Image size 2352x1568: 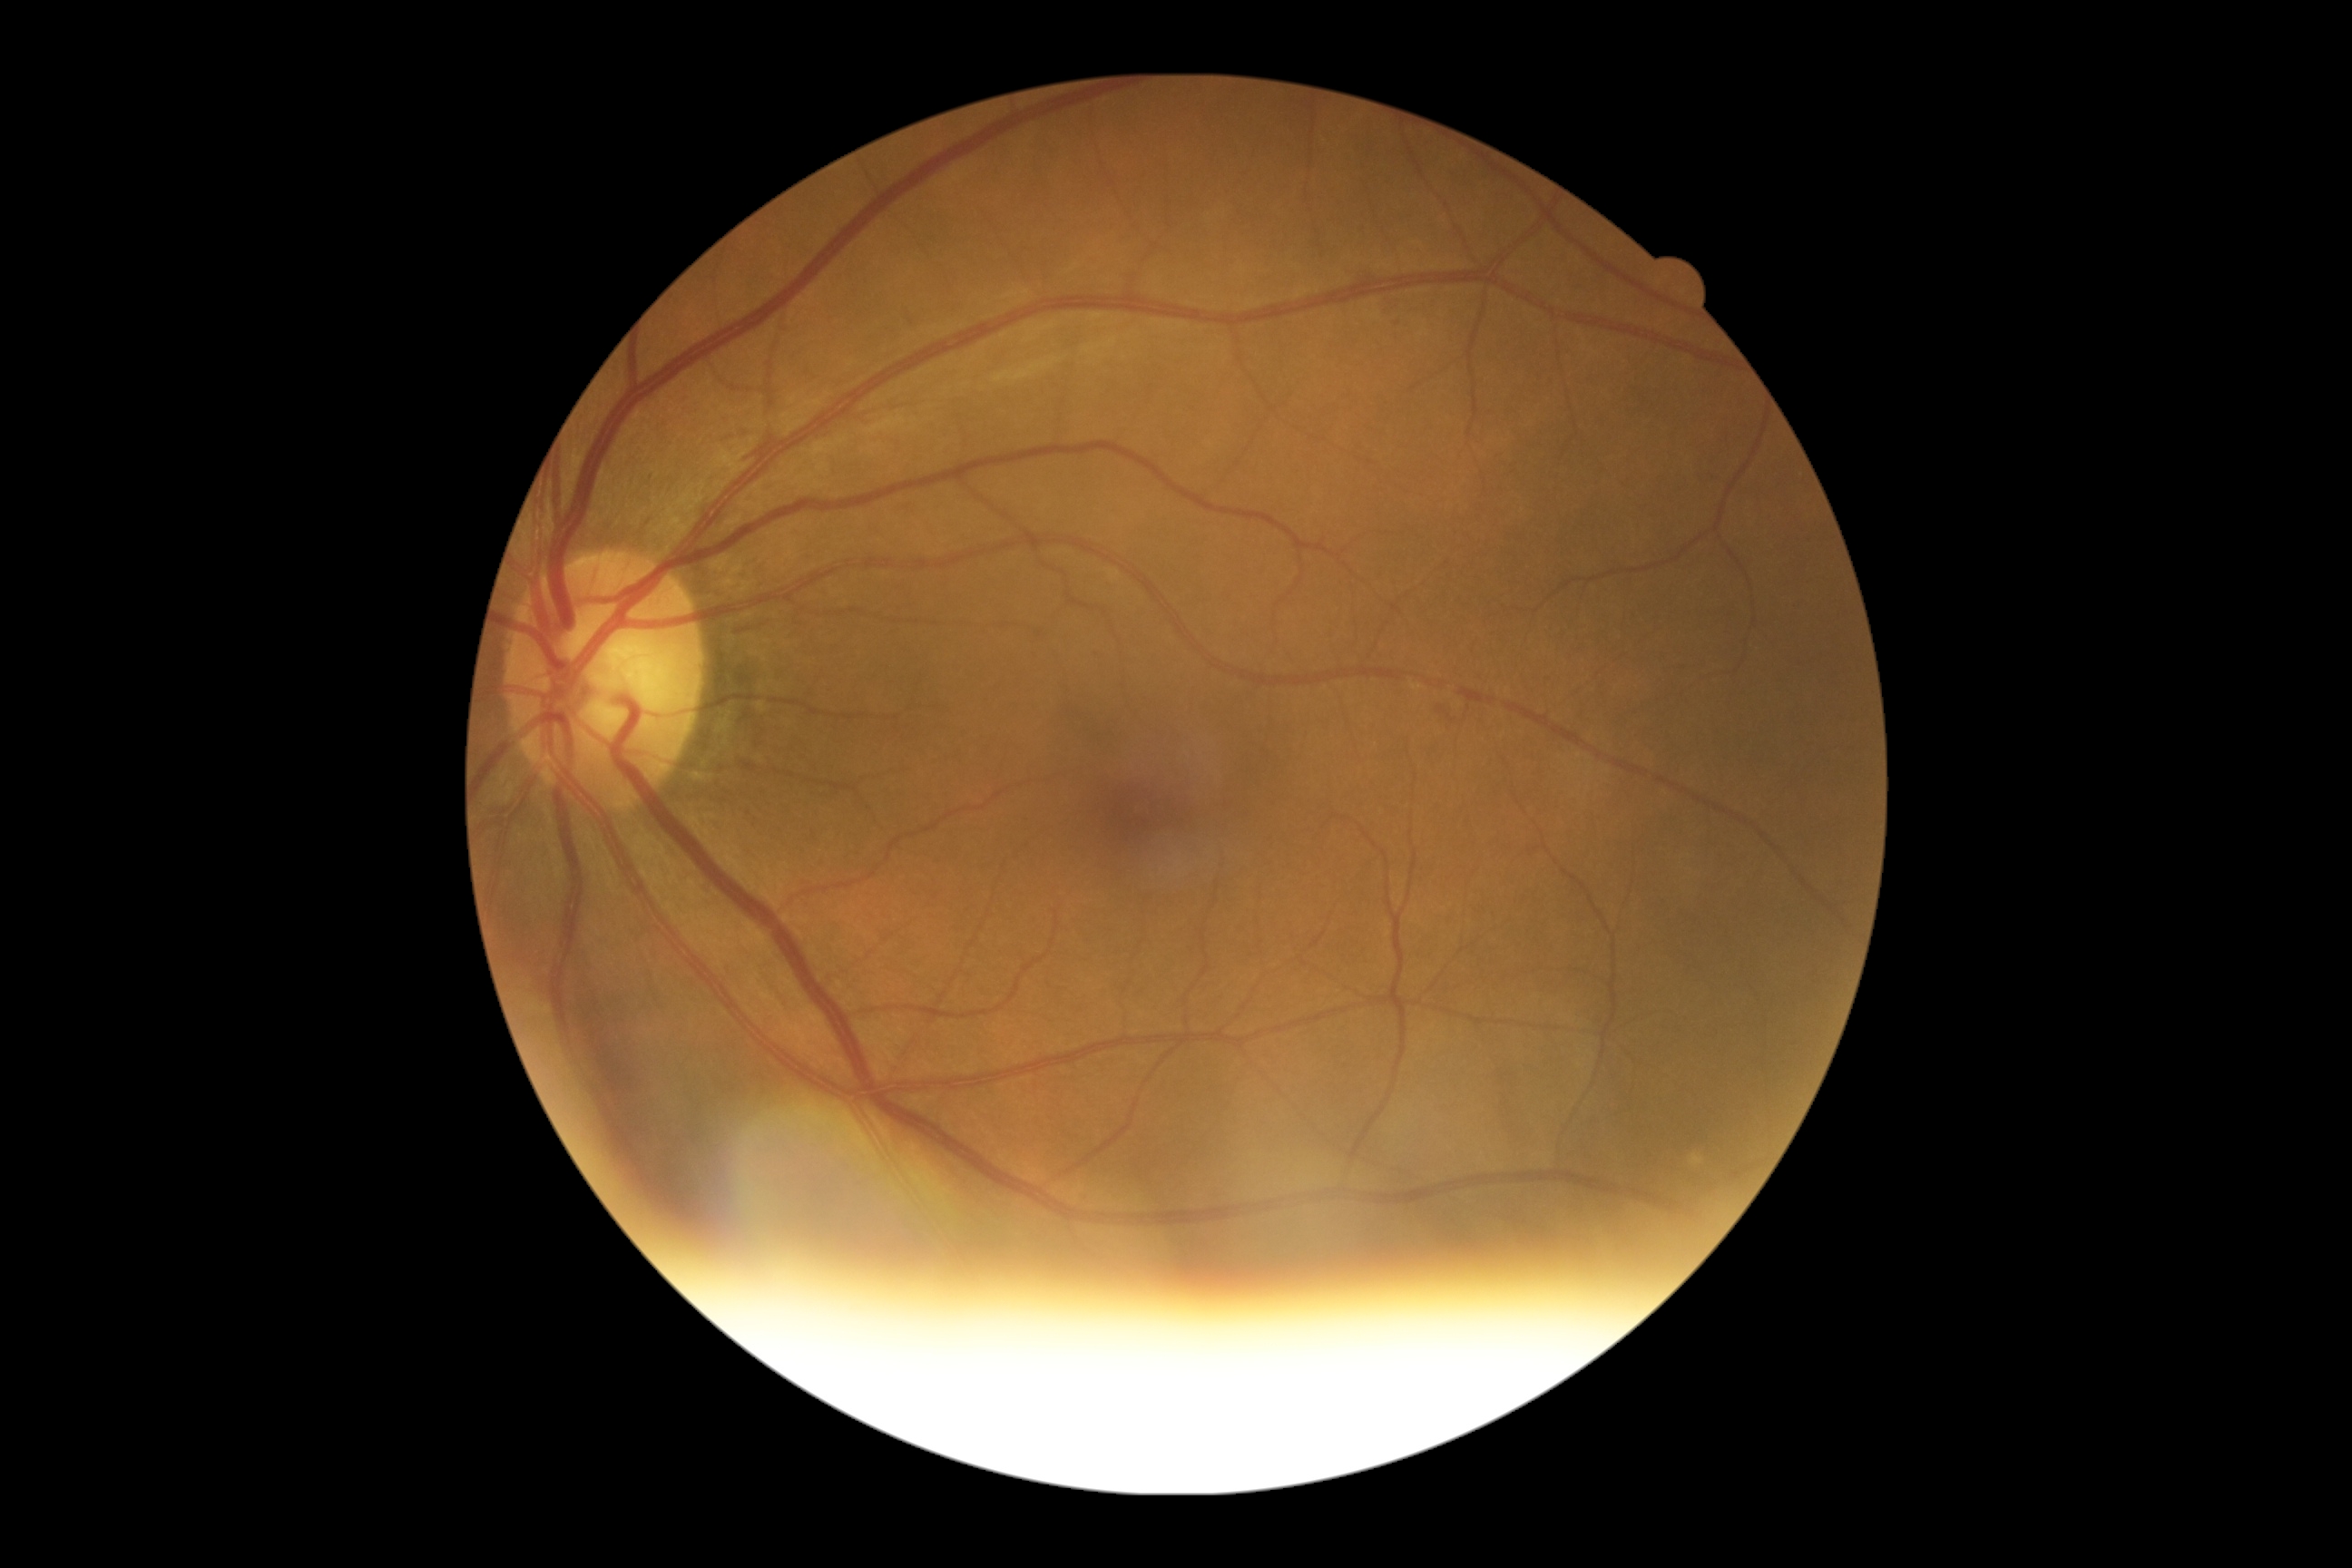

Diabetic retinopathy (DR): 2/4 — more than just microaneurysms but less than severe NPDR.